RetCam wide-field infant fundus image · image size 640x480 · camera: Clarity RetCam 3 (130° FOV):
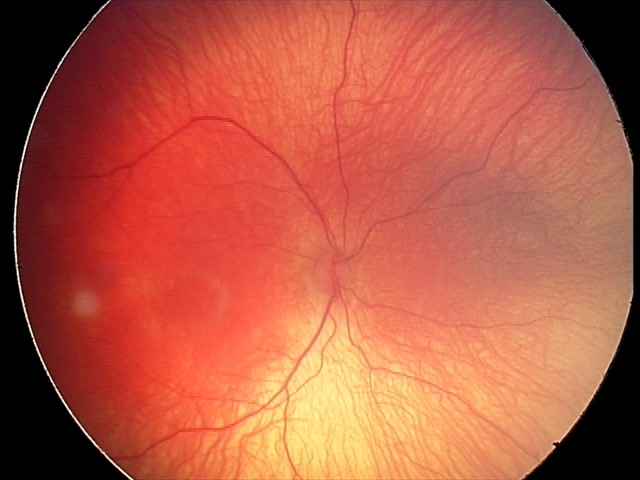 Screening series with retinopathy of prematurity stage 1. Without plus disease.